1924x1556, wide-field retinal mosaic image: 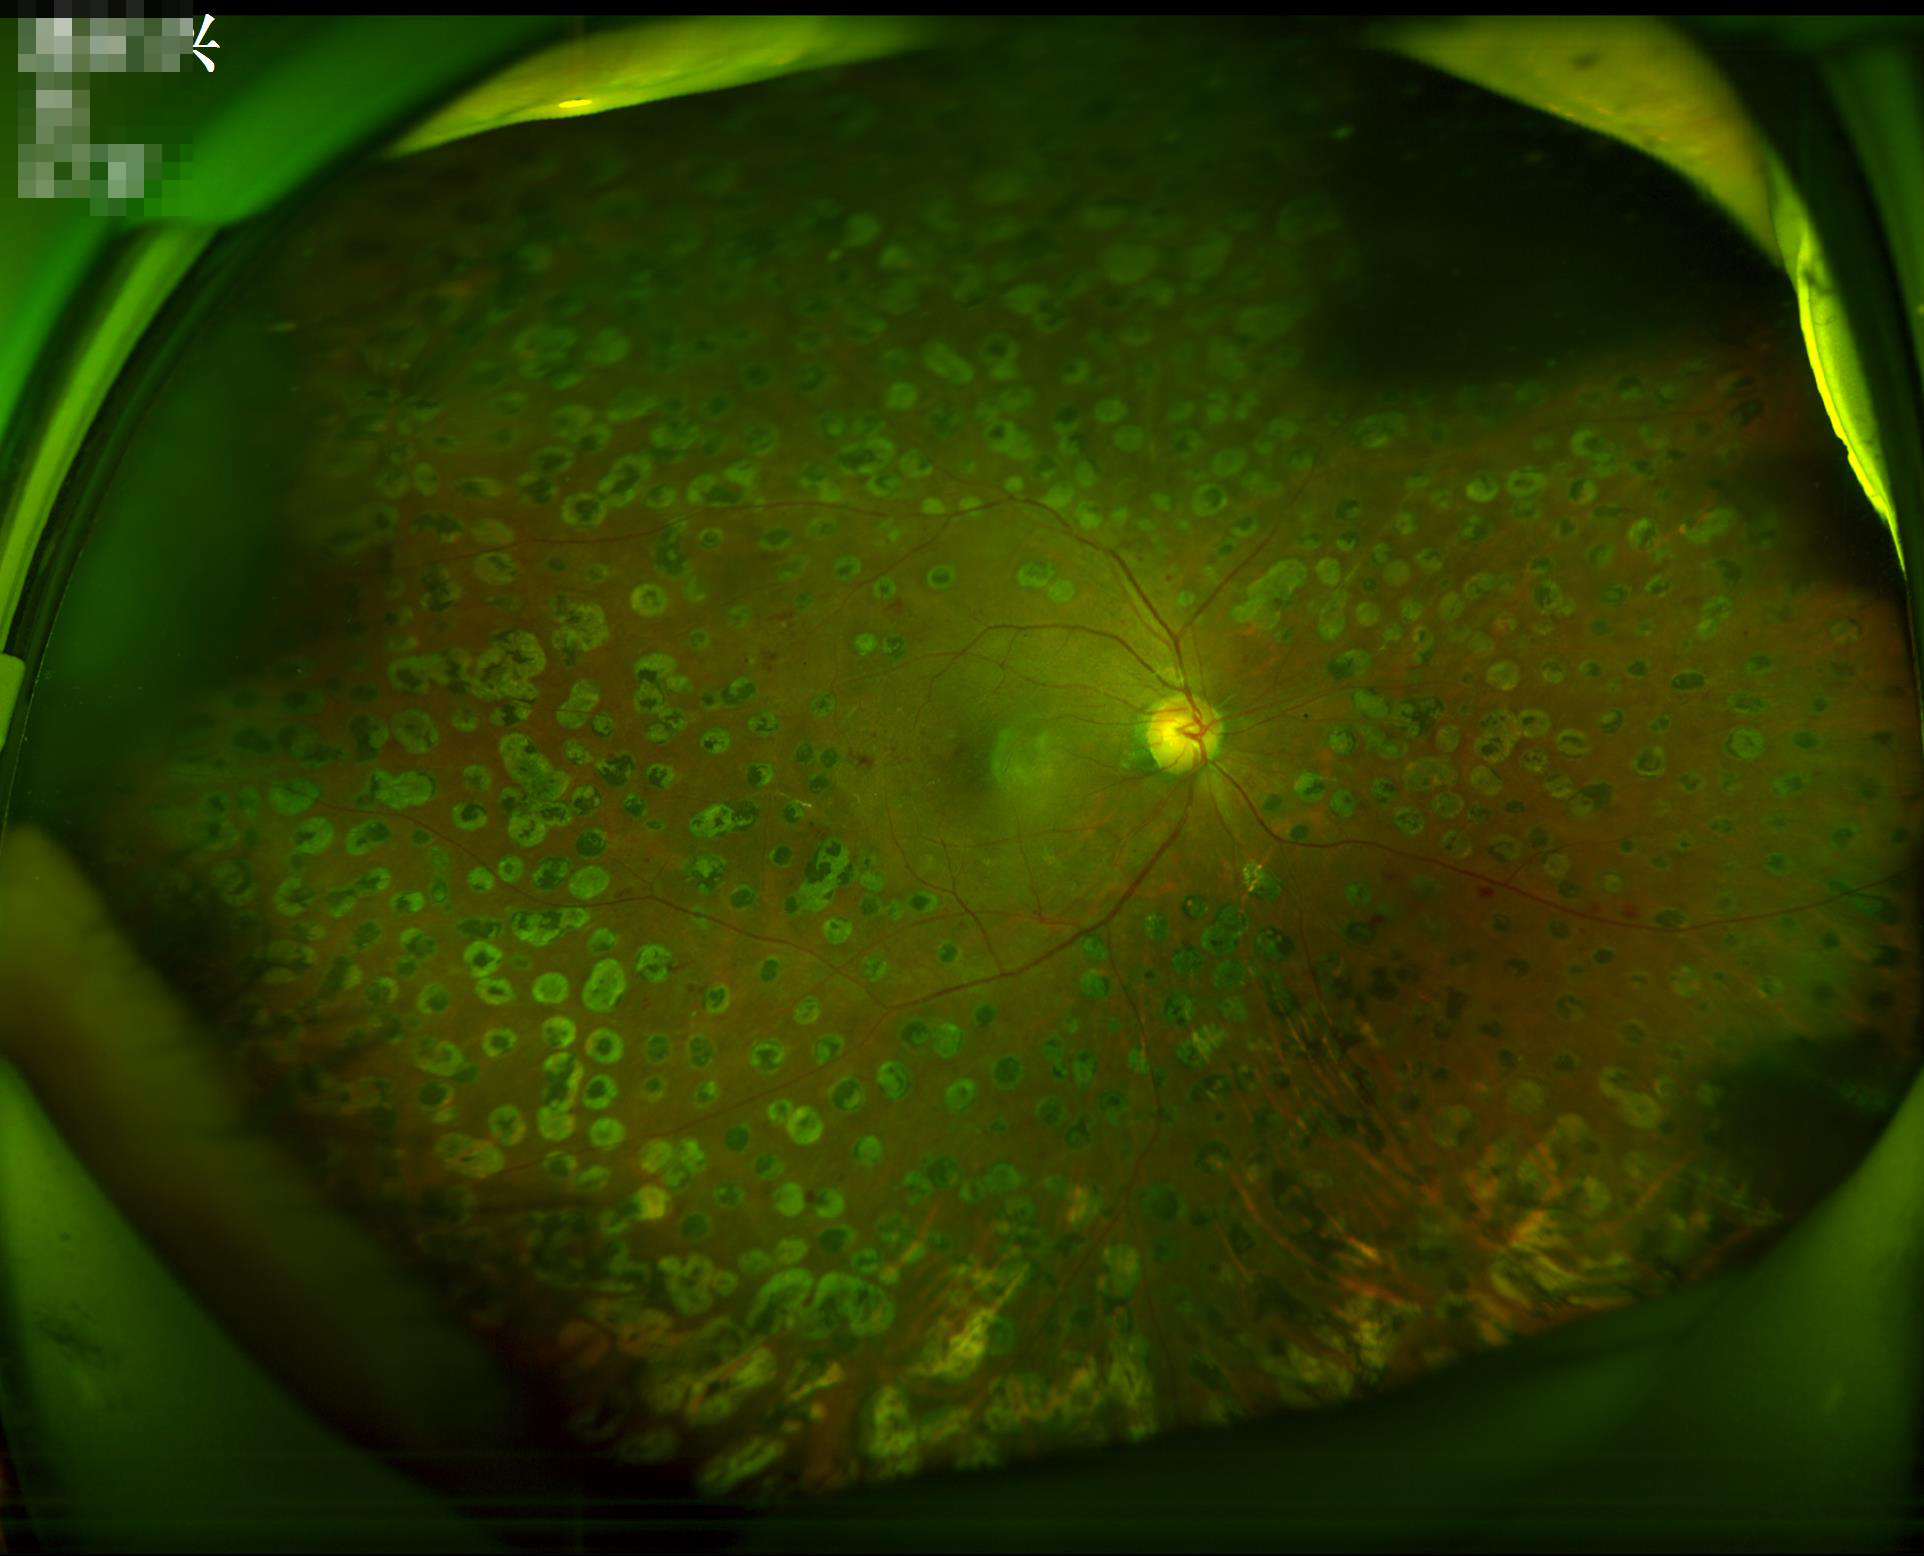

{"illumination": "even and well-balanced", "overall_quality": "good, gradable", "contrast": "wide intensity range, structures distinguishable", "clarity": "clear with no noticeable blur"}